NIDEK AFC-230 · Davis DR grading · without pupil dilation · 45° field of view
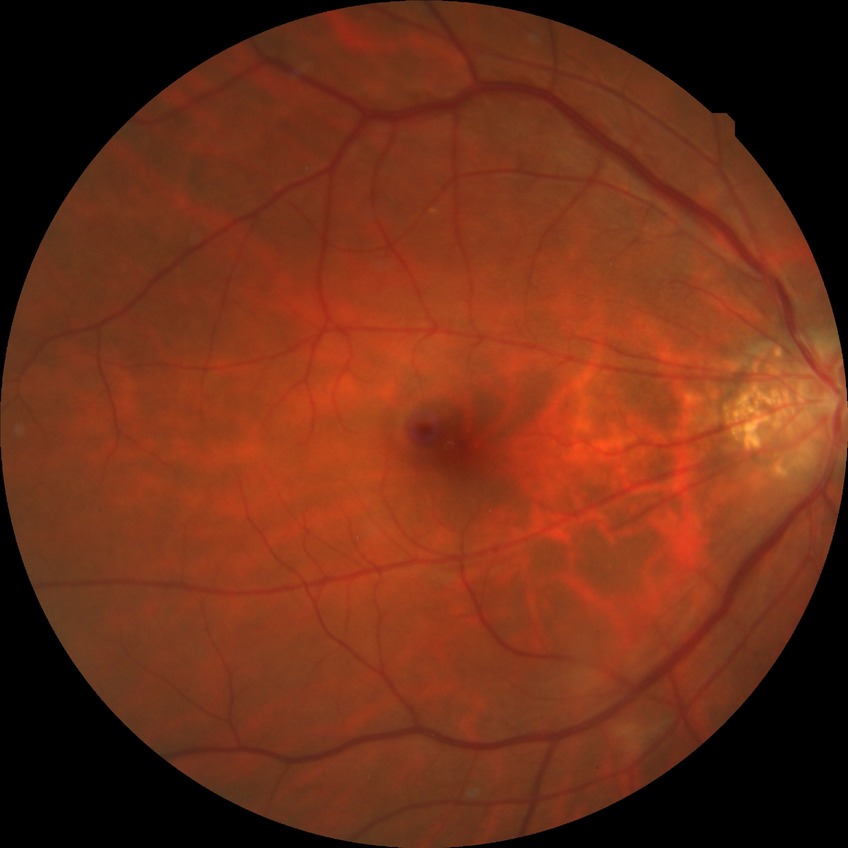

Retinopathy stage is no diabetic retinopathy.